Modified Davis grading:
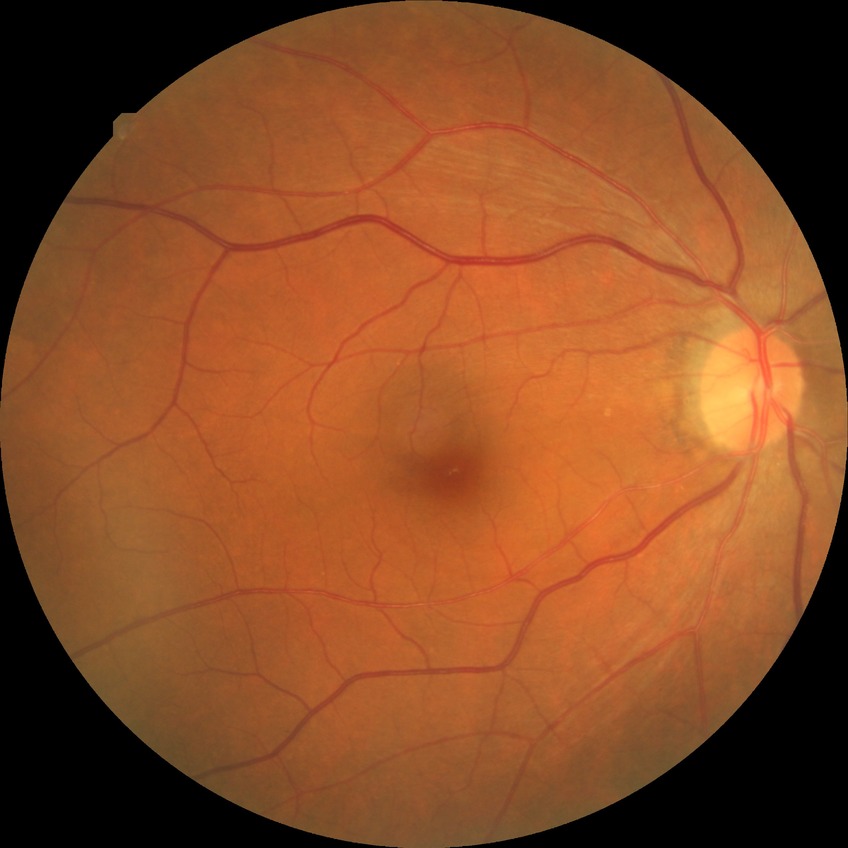
DR class: non-proliferative diabetic retinopathy. Diabetic retinopathy (DR) is SDR (simple diabetic retinopathy).